Pediatric wide-field fundus photograph.
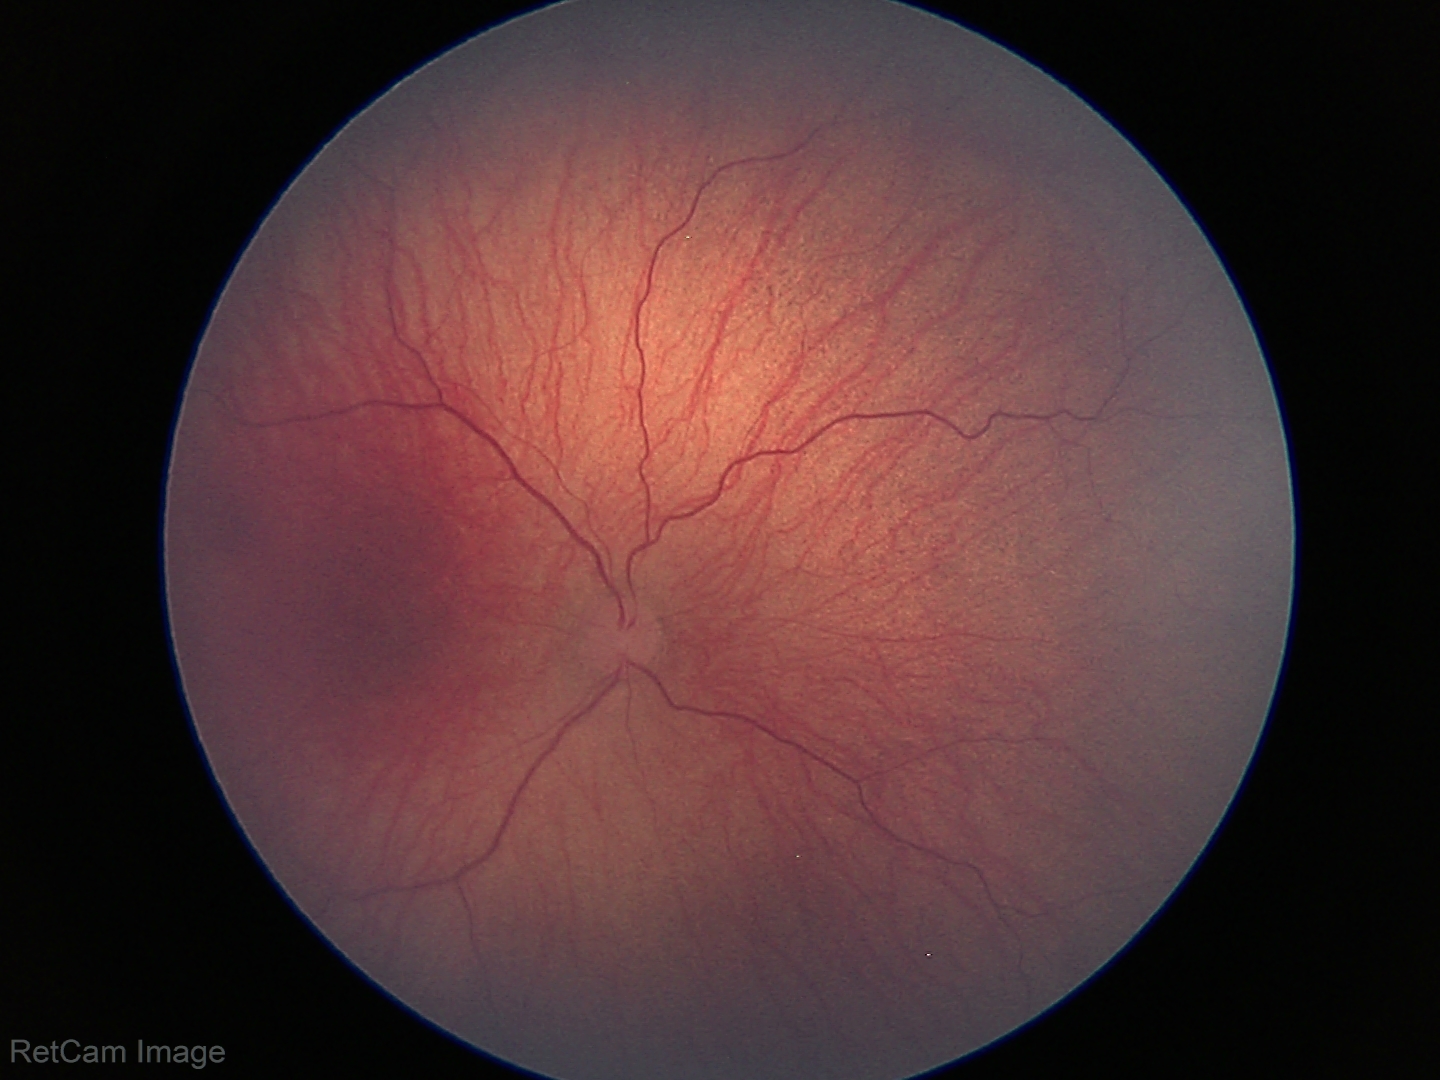
Screening series with retinopathy of prematurity (ROP) stage 1. Plus disease absent.